Topcon TRC-NW8.
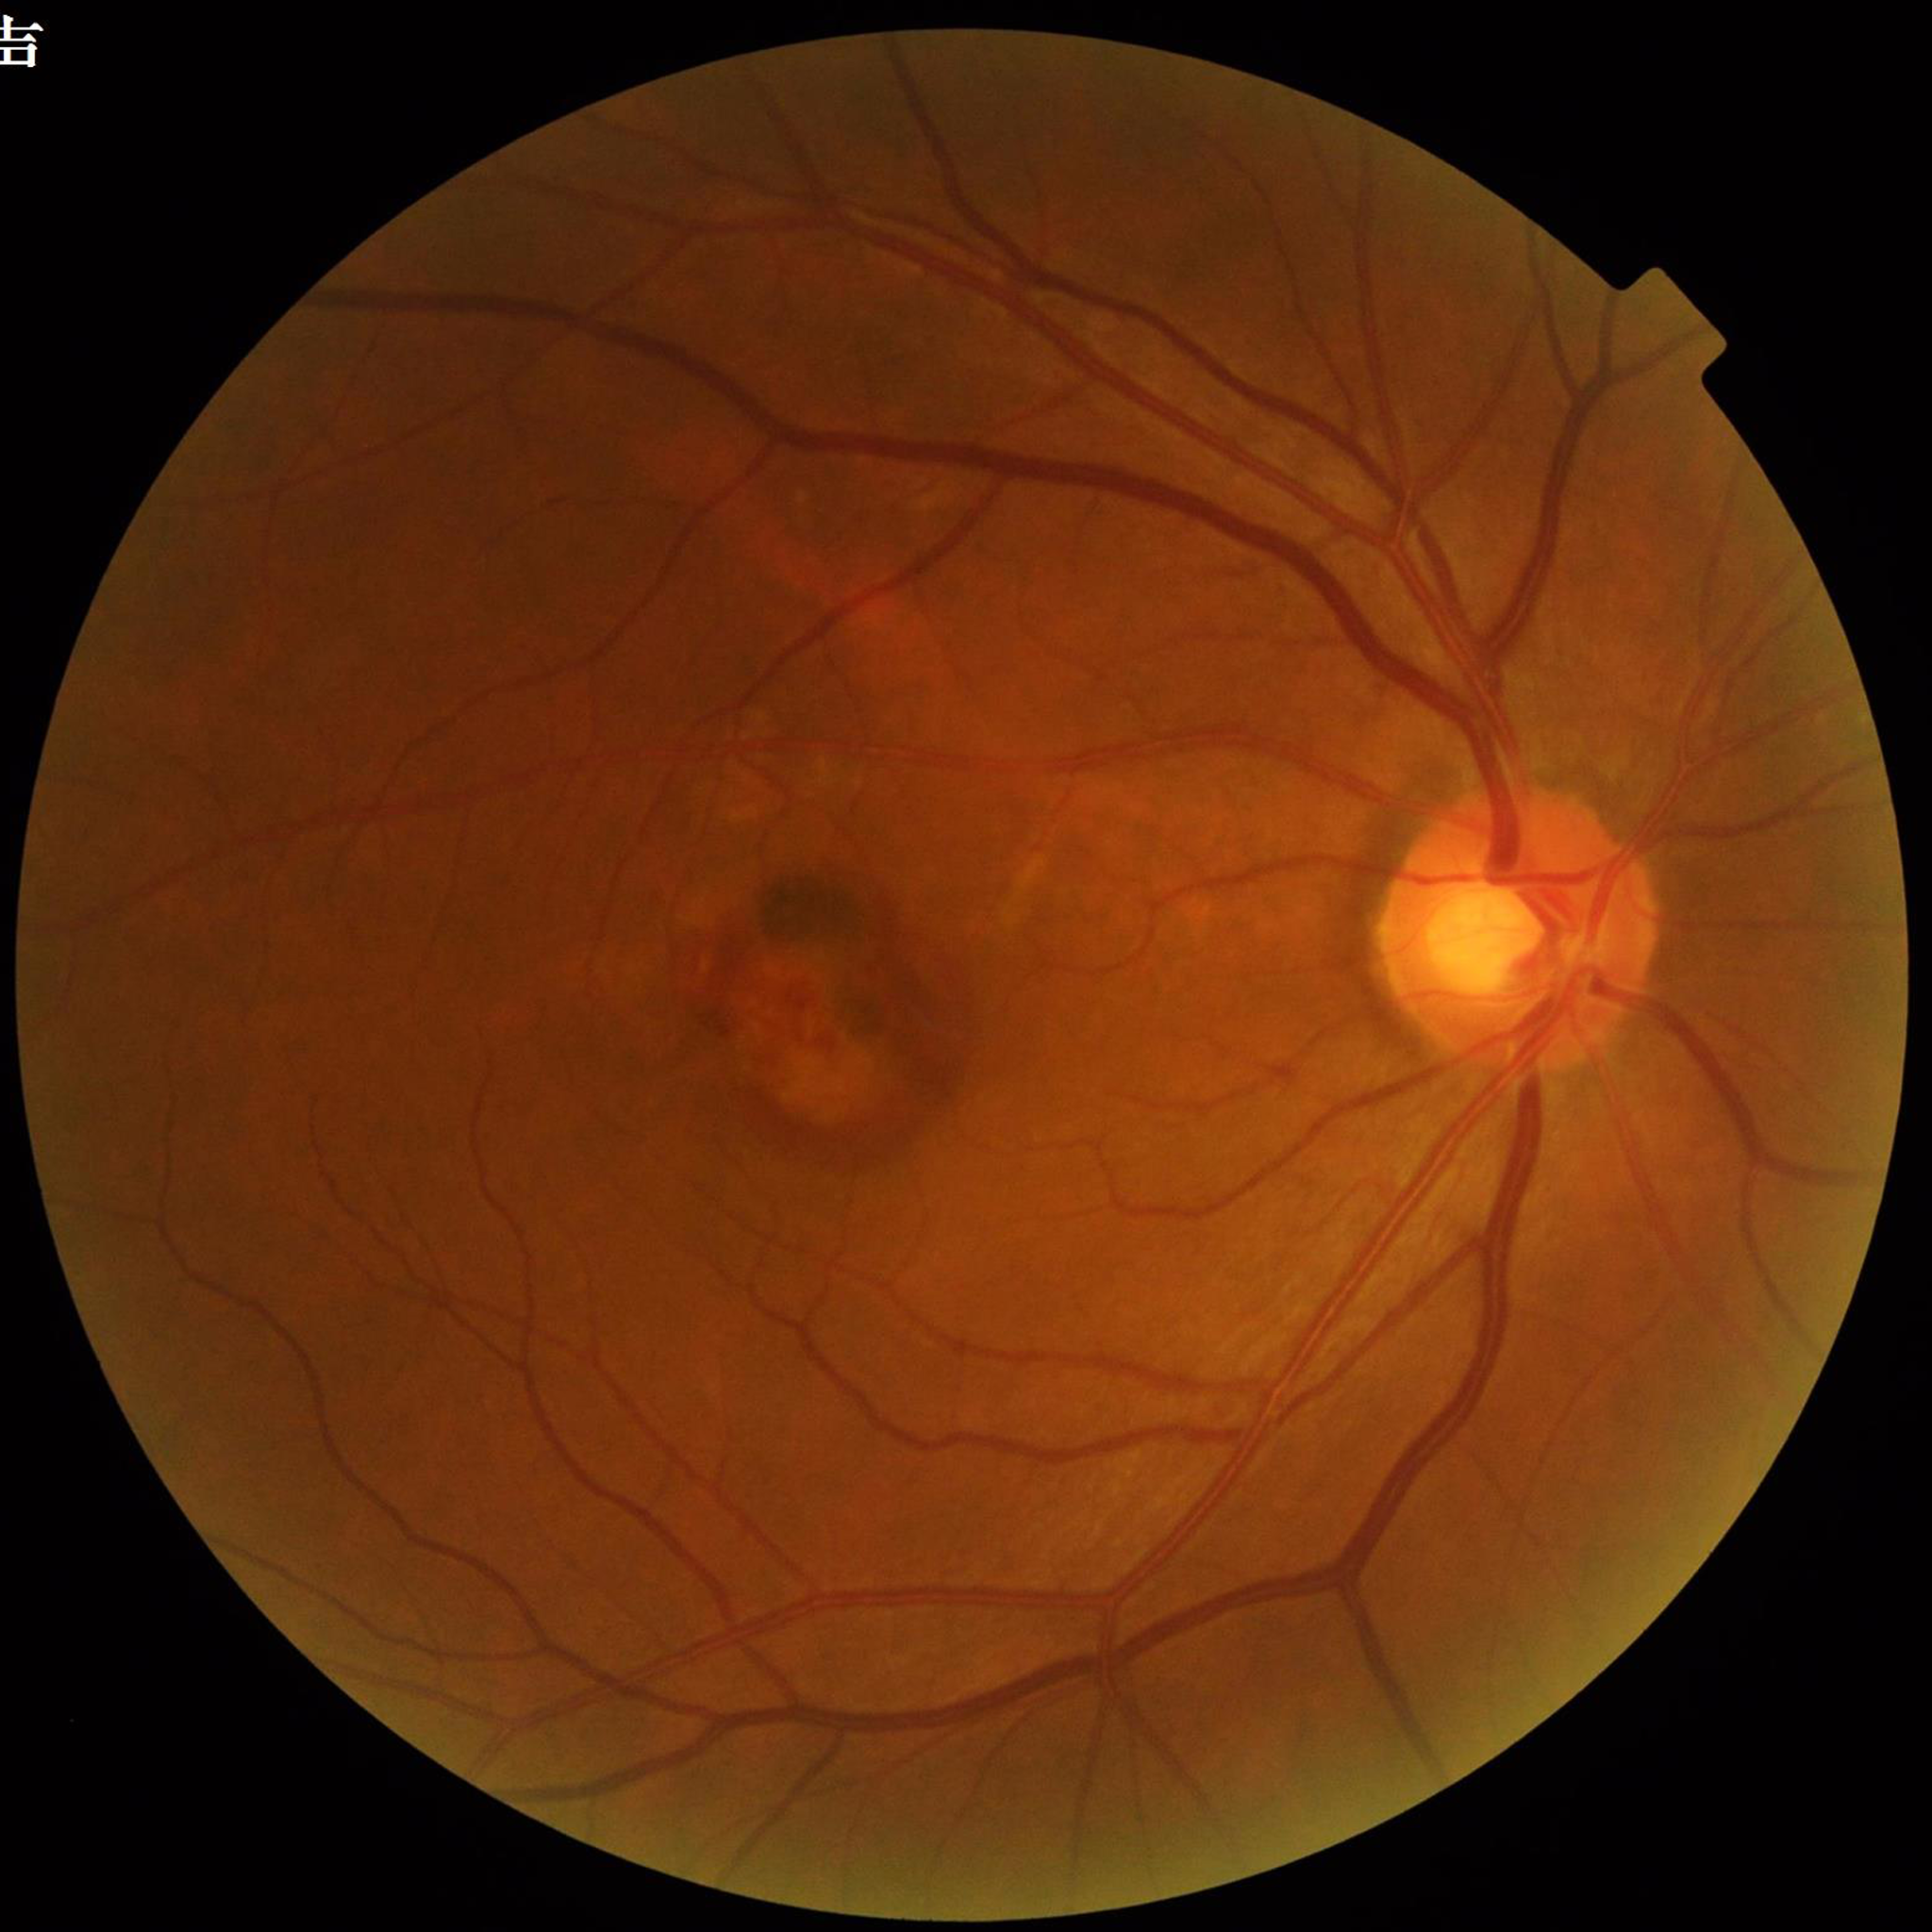 Automated quality assessment: adequate
Diagnosis: age-related macular degeneration (AMD)